Pediatric retinal photograph (wide-field) · Phoenix ICON, 100° FOV:
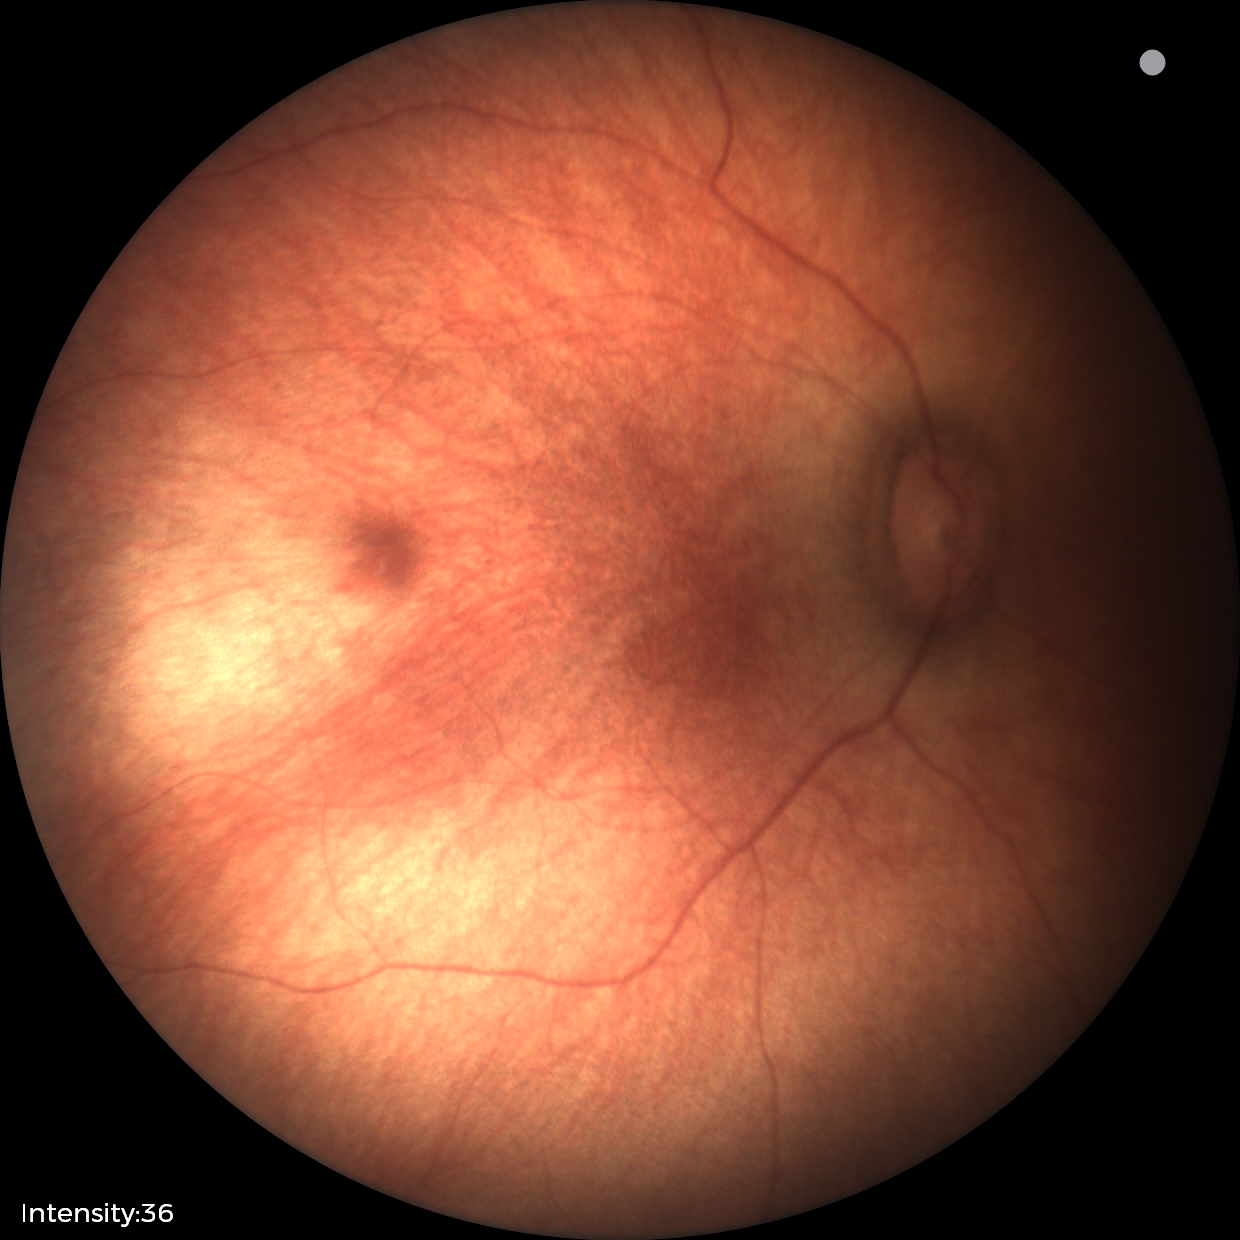

Screening examination with no abnormal retinal findings.